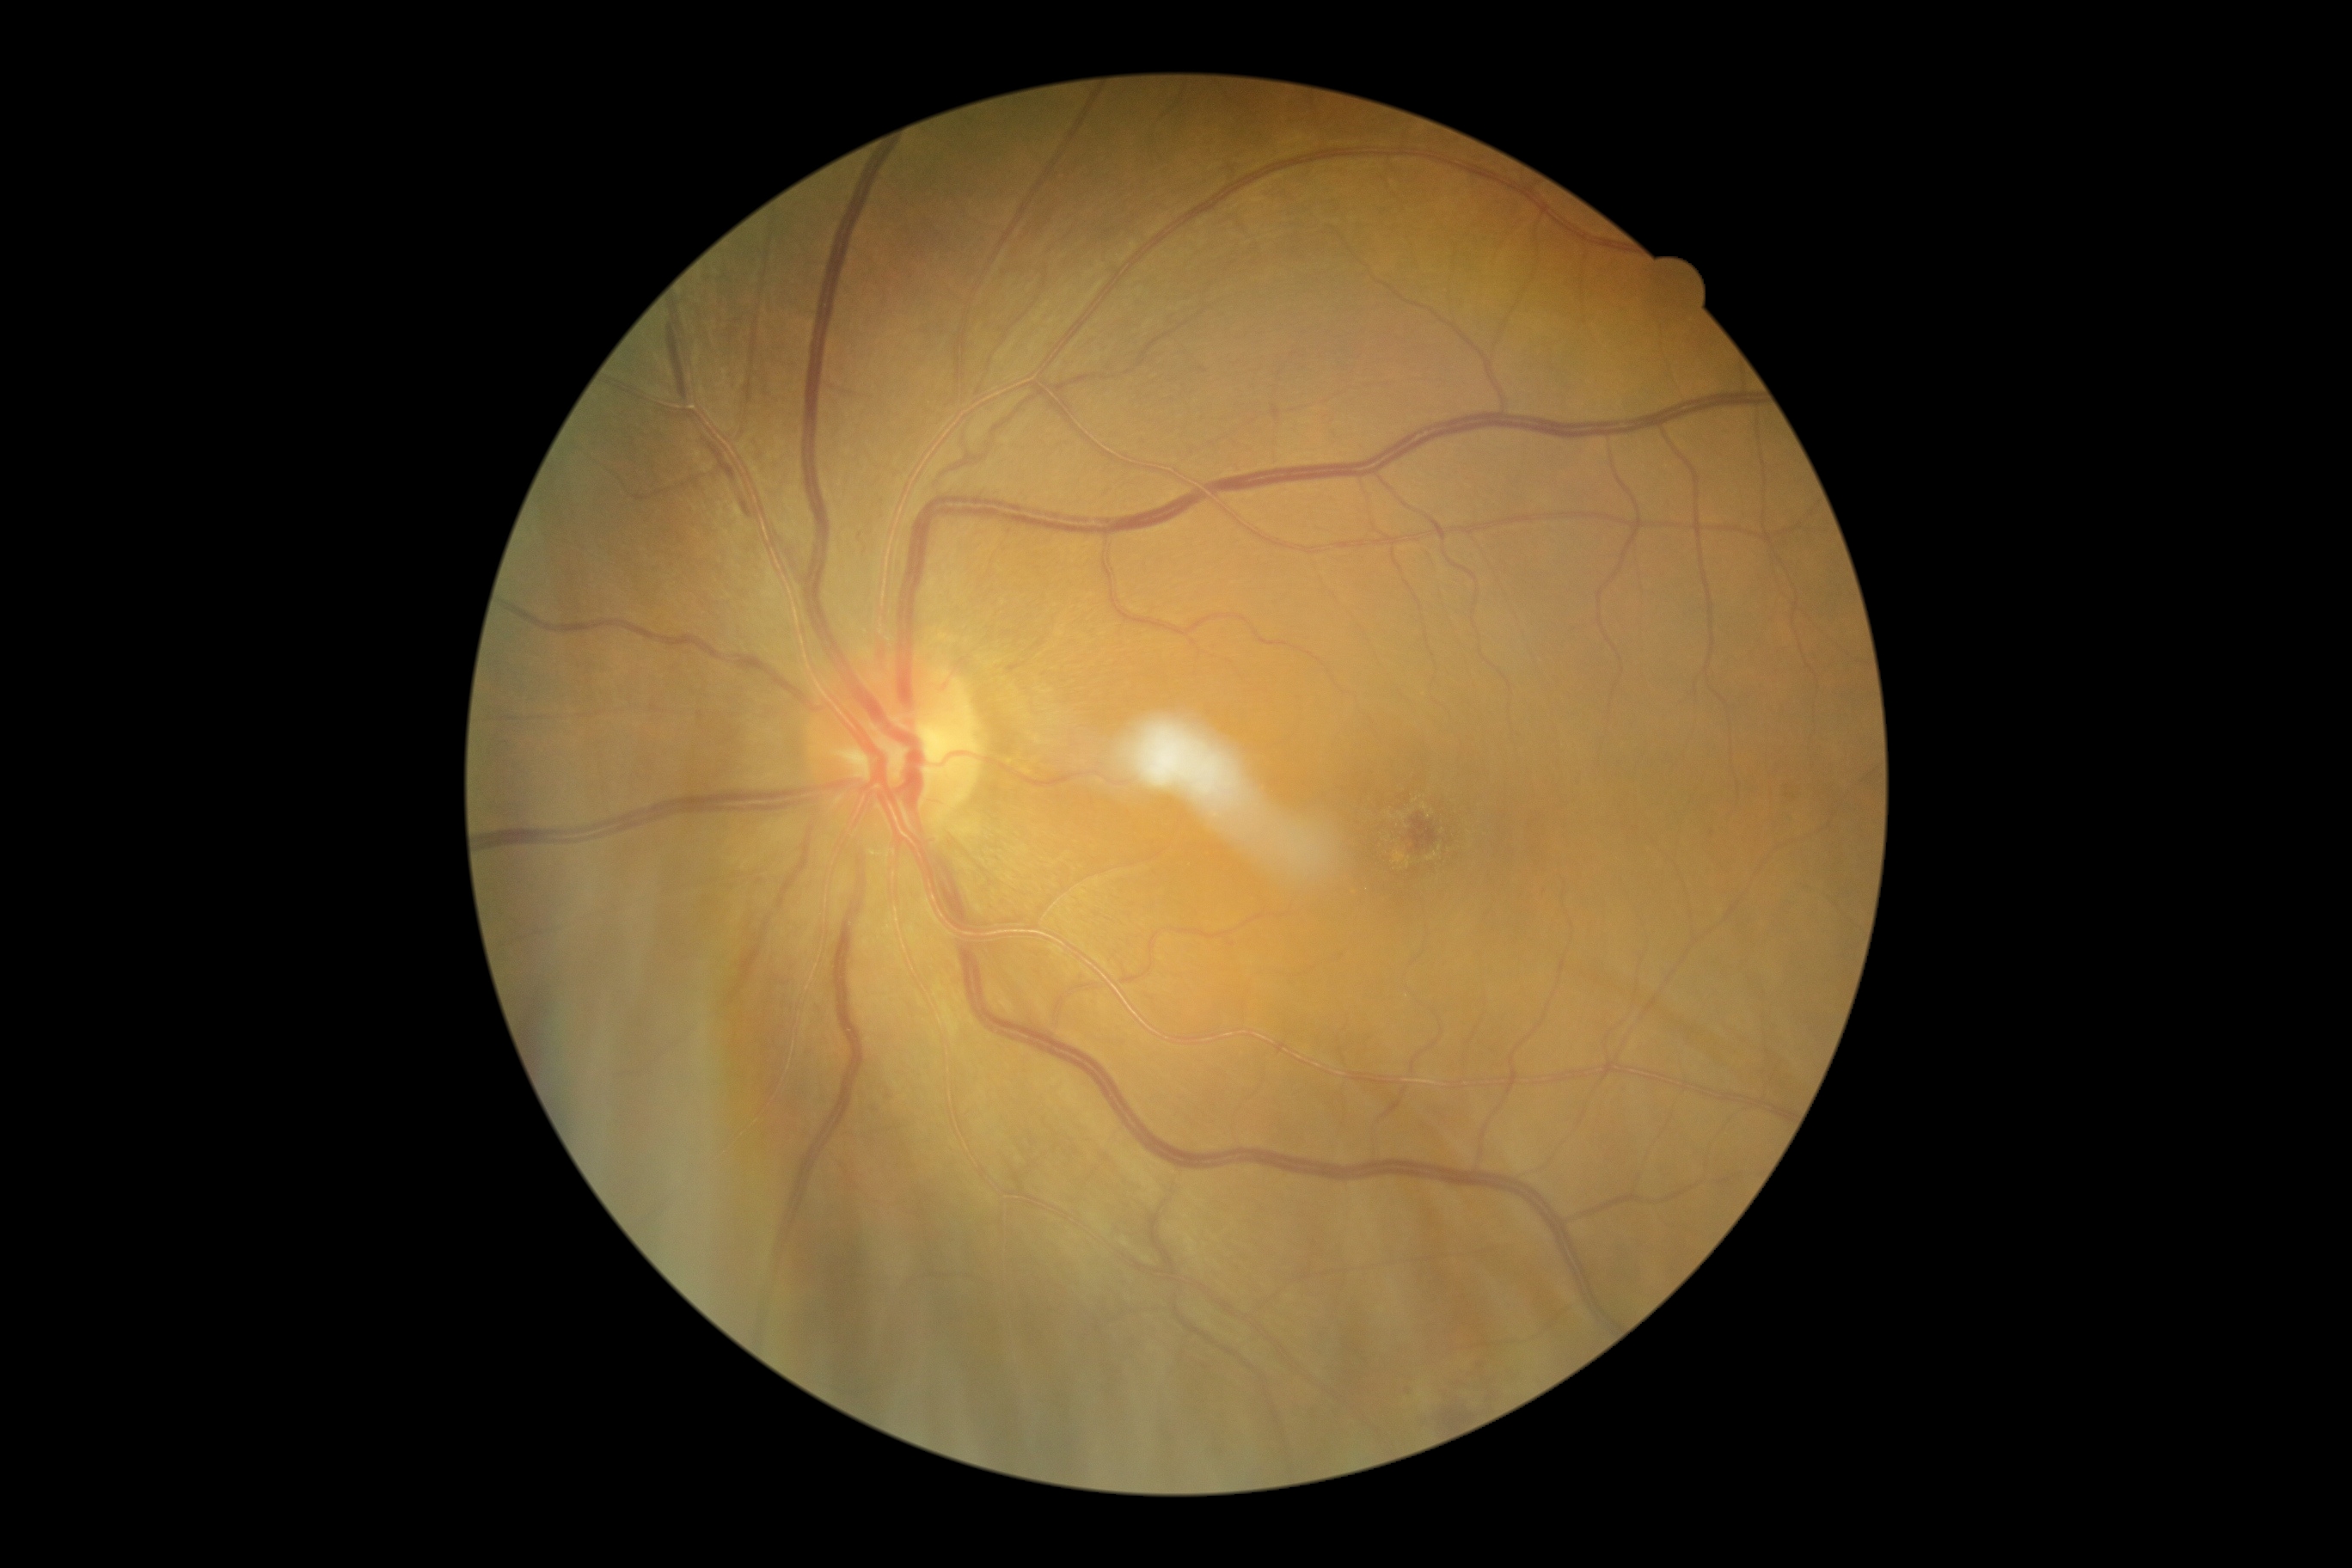 {
  "dr_grade": "grade 2 — more than just microaneurysms but less than severe NPDR"
}